Color fundus photograph.
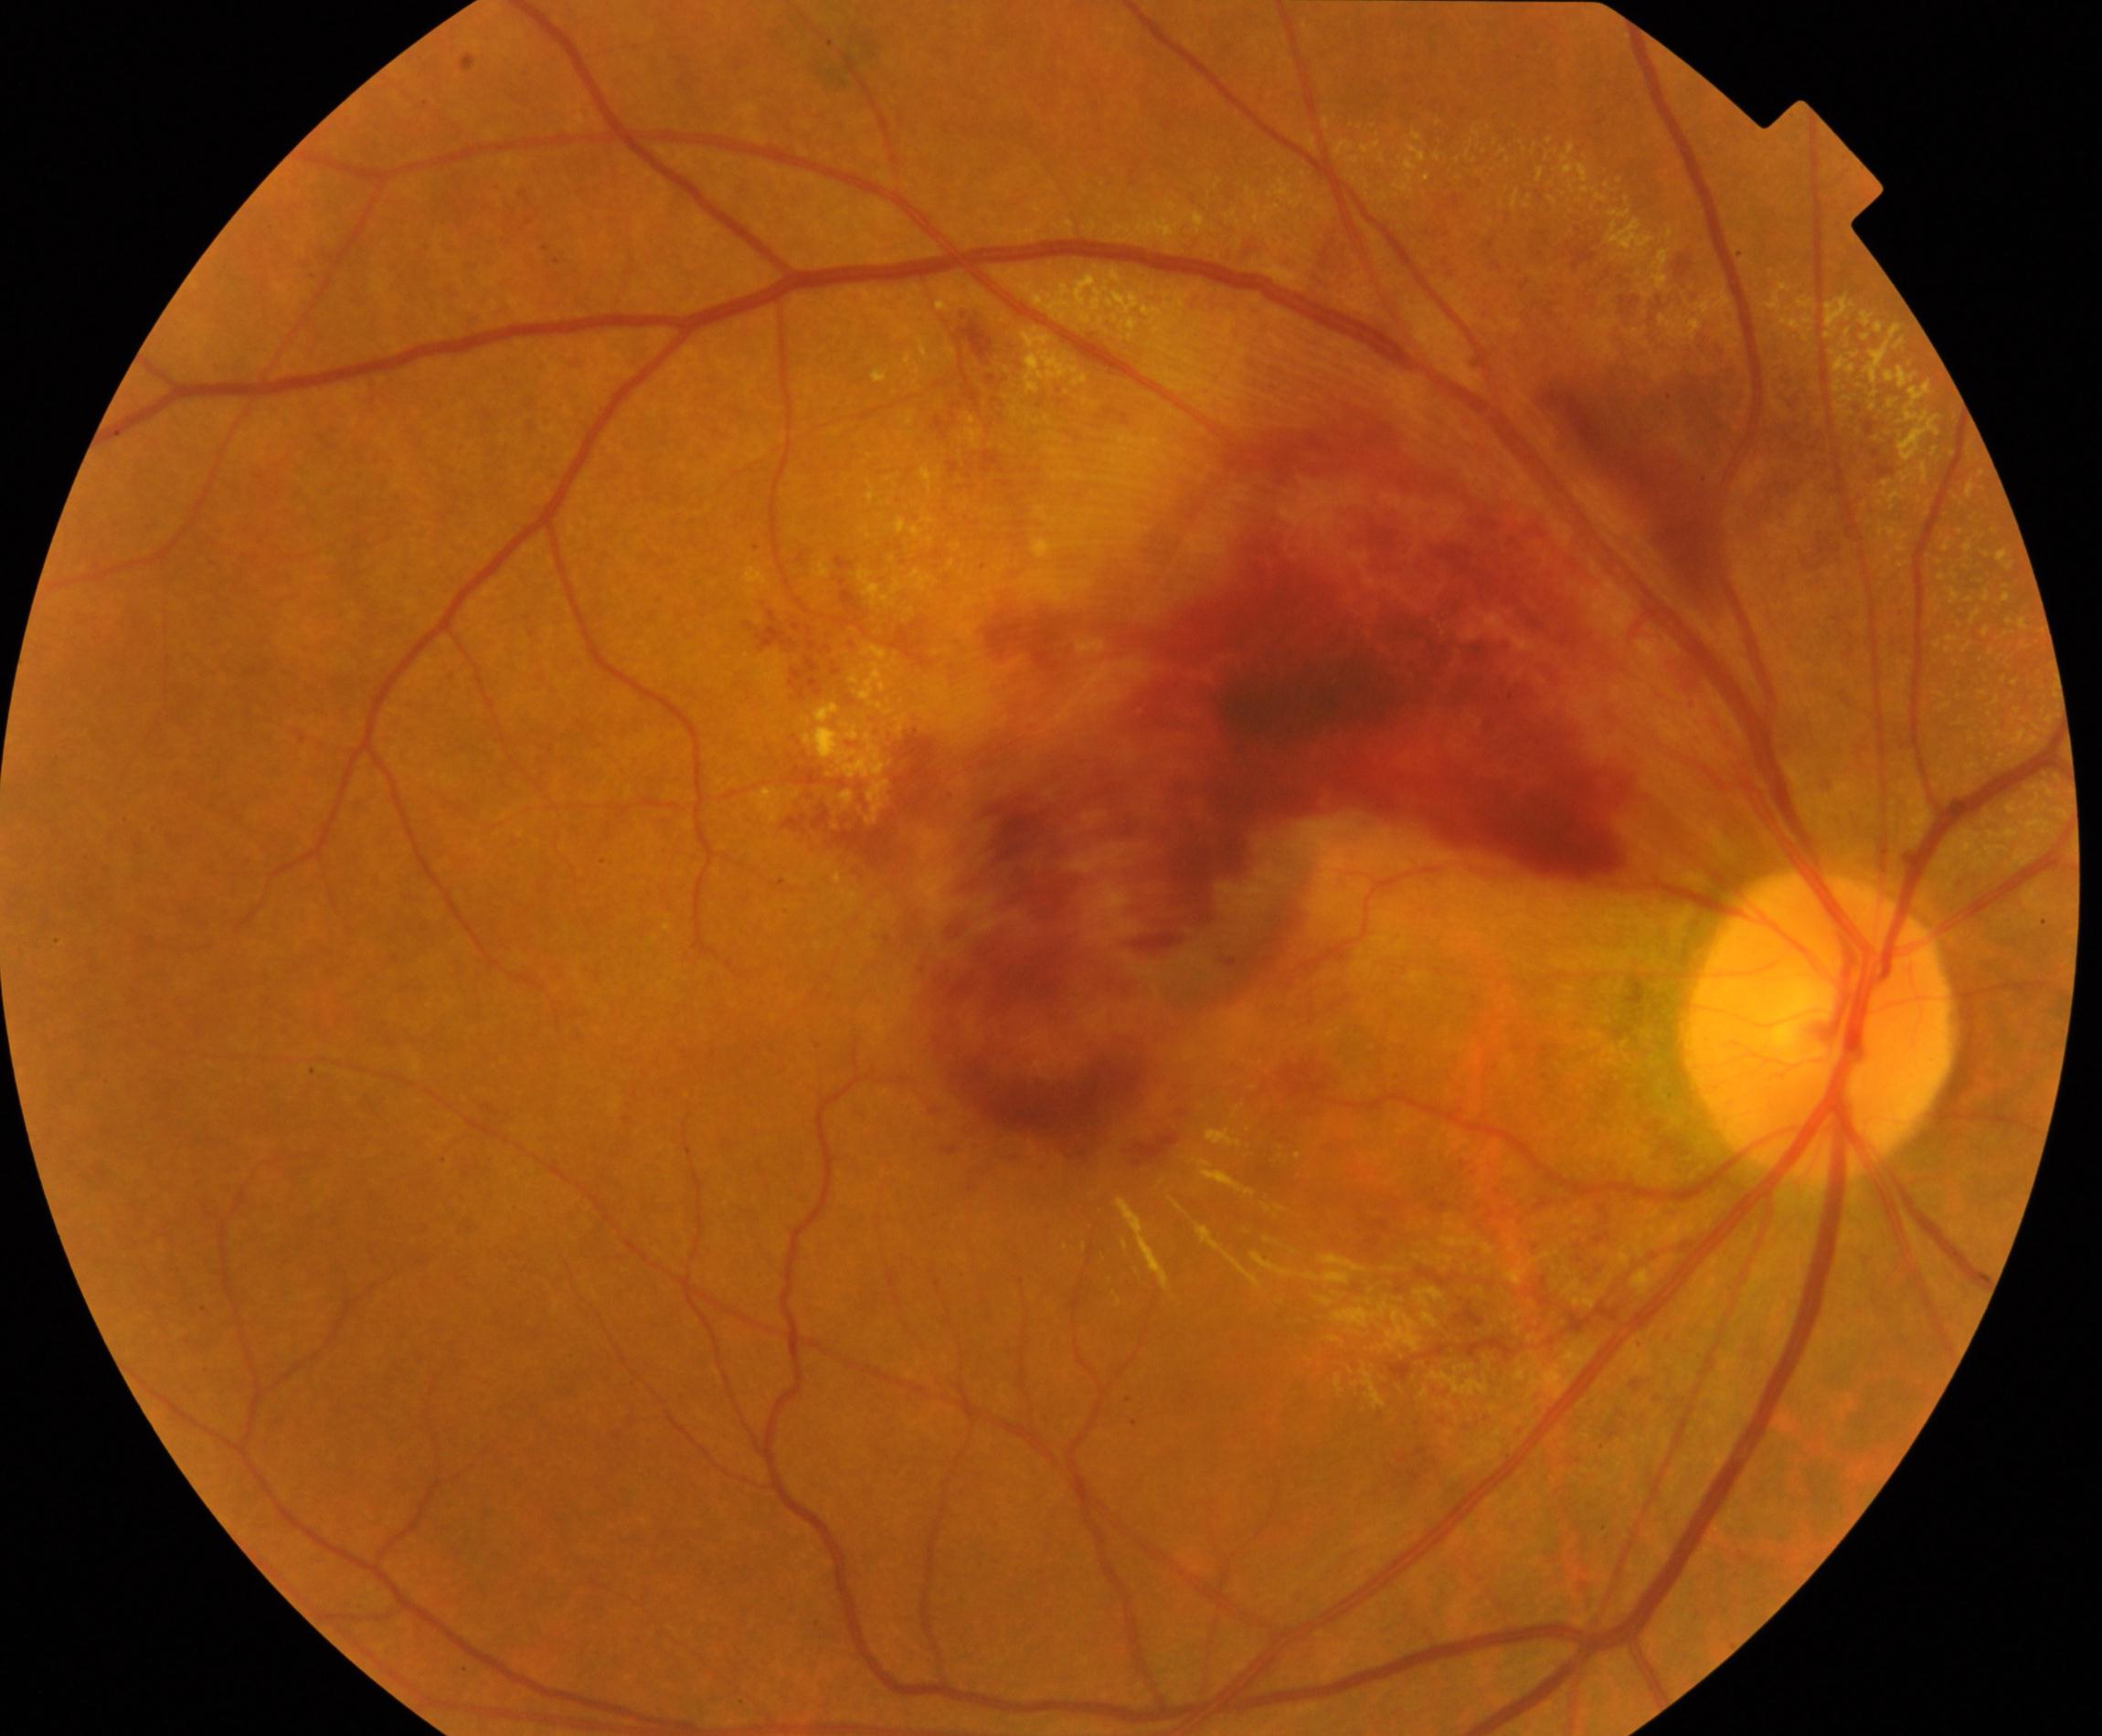

Consistent with branch retinal vein occlusion (BRVO).